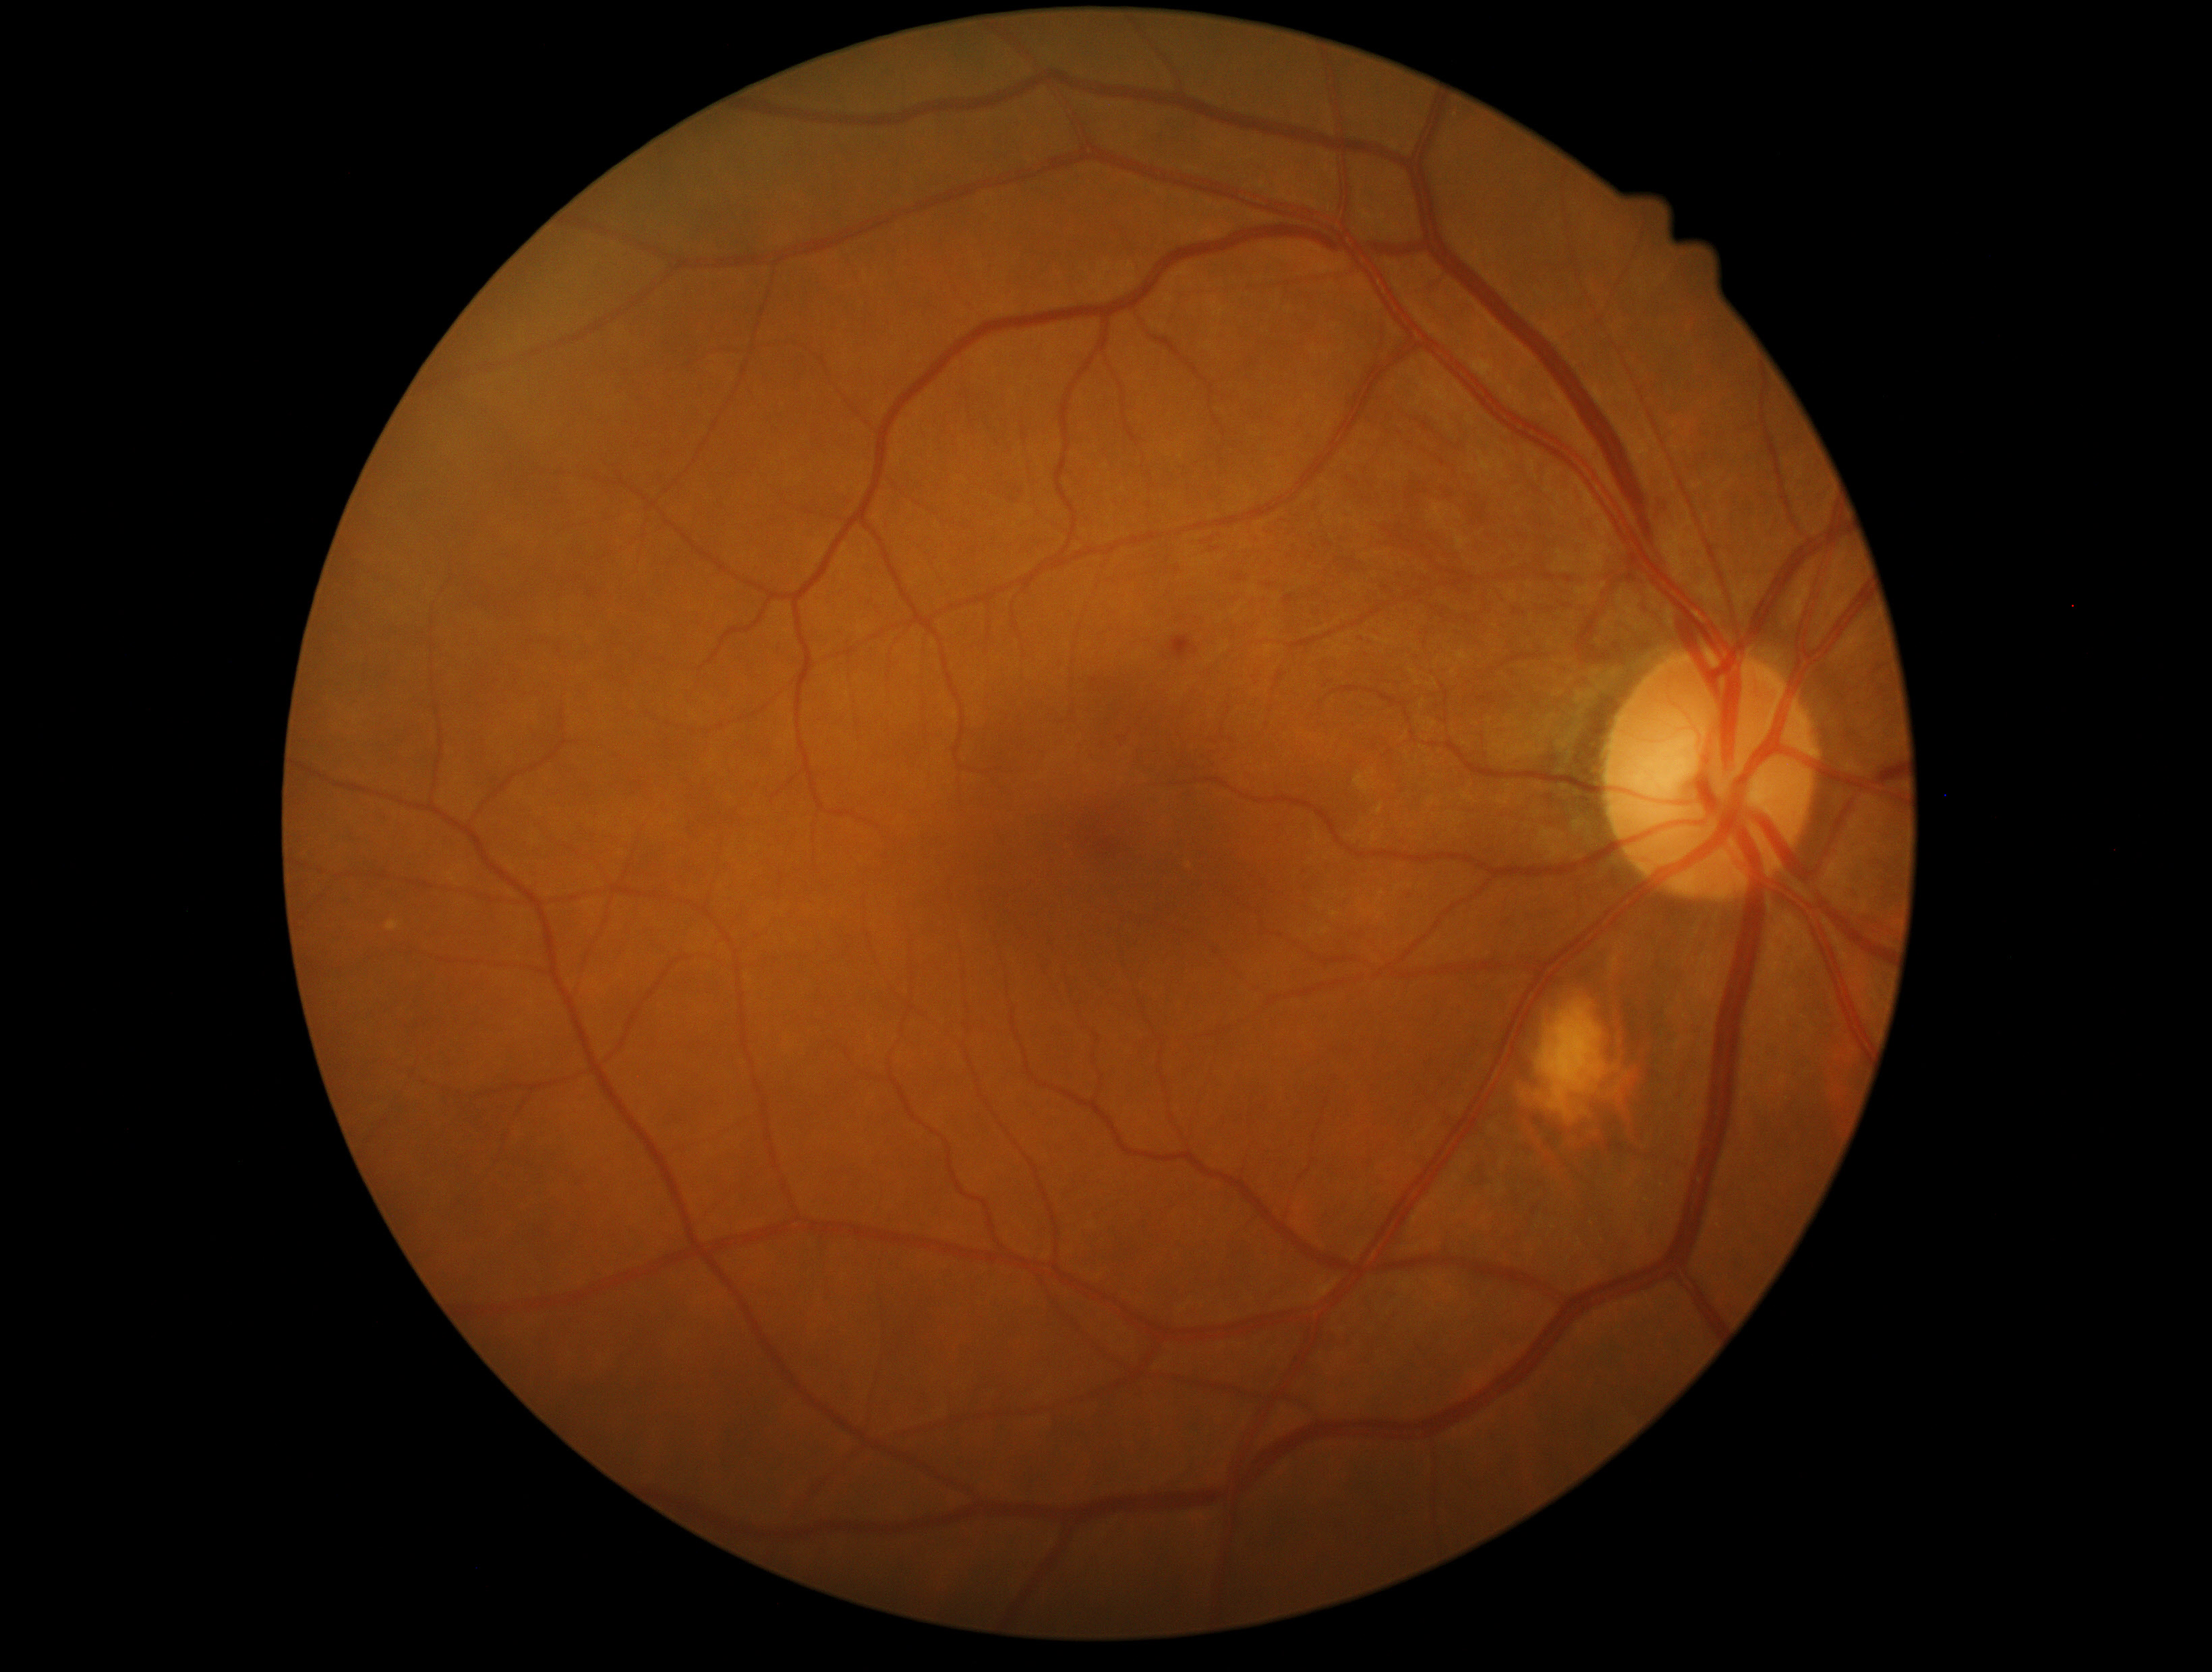 Diabetic retinopathy (DR): mild NPDR (grade 1). The retinopathy is classified as non-proliferative diabetic retinopathy.